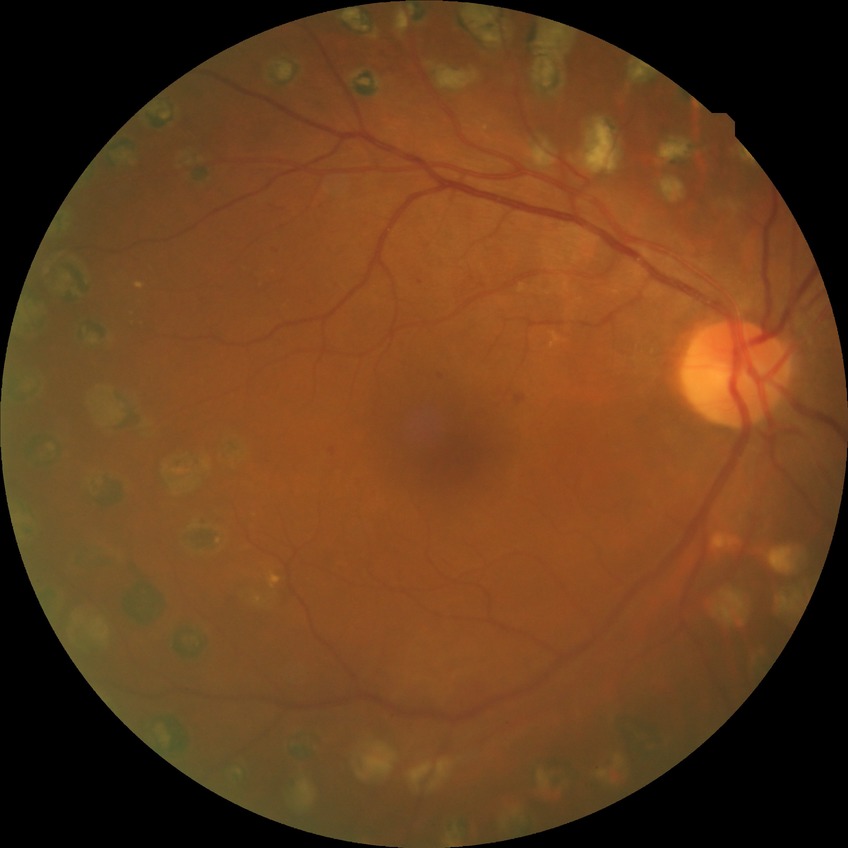

Retinopathy grade is proliferative diabetic retinopathy.